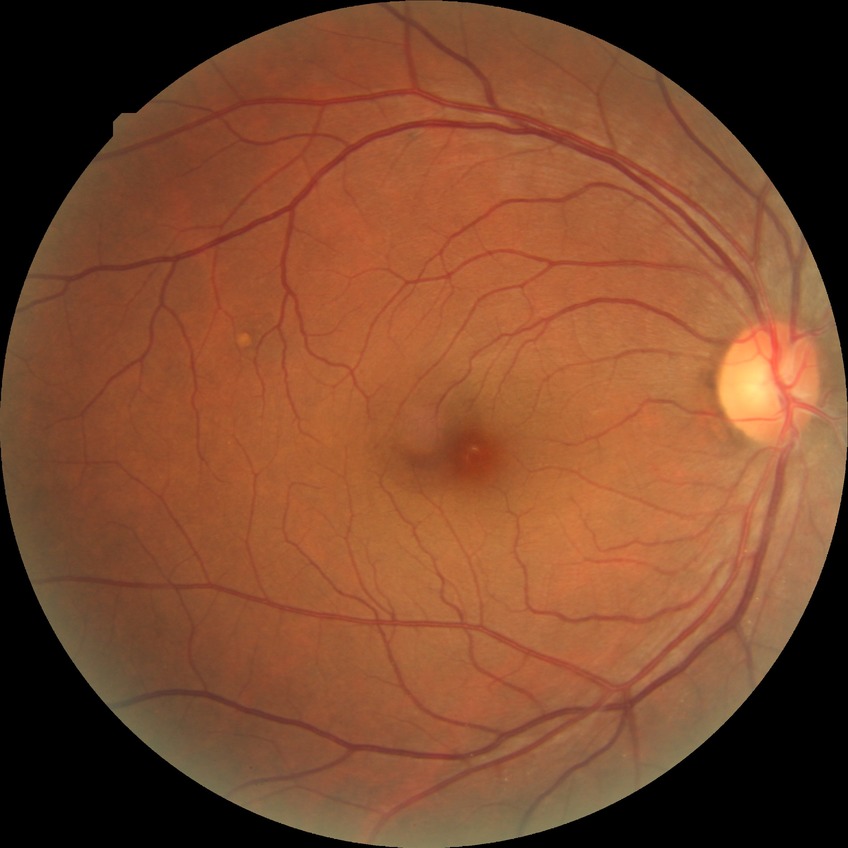   dr_impression: negative for DR
  davis_grade: NDR